Acquired with a NIDEK AFC-230 · retinal fundus photograph · 848 by 848 pixels · 45° field of view.
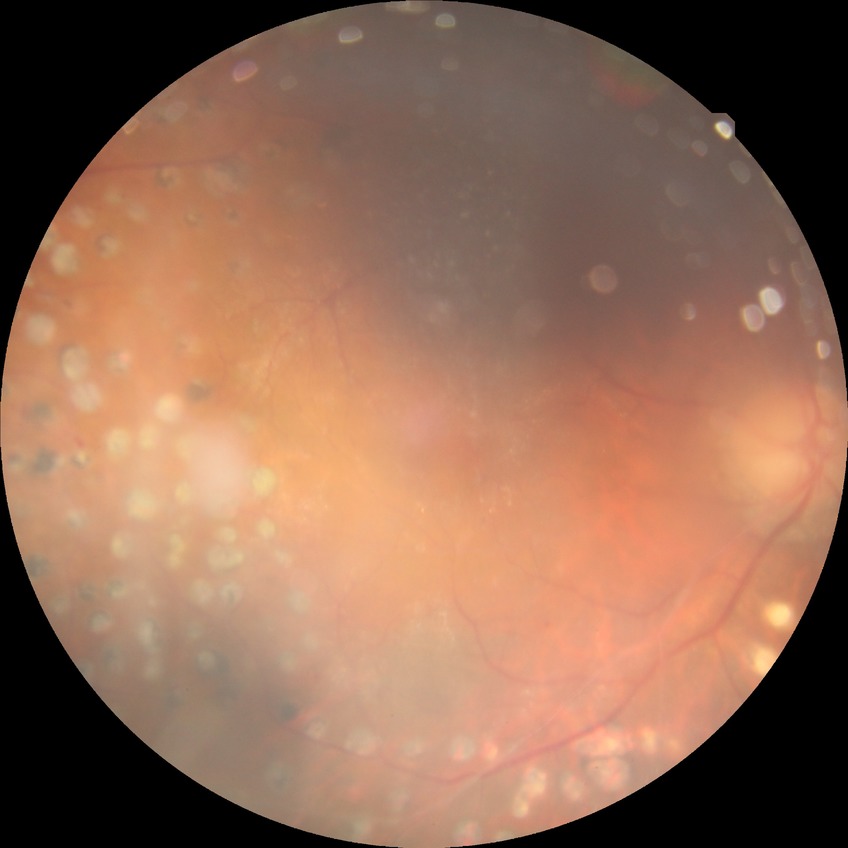 Modified Davis grading: proliferative diabetic retinopathy.